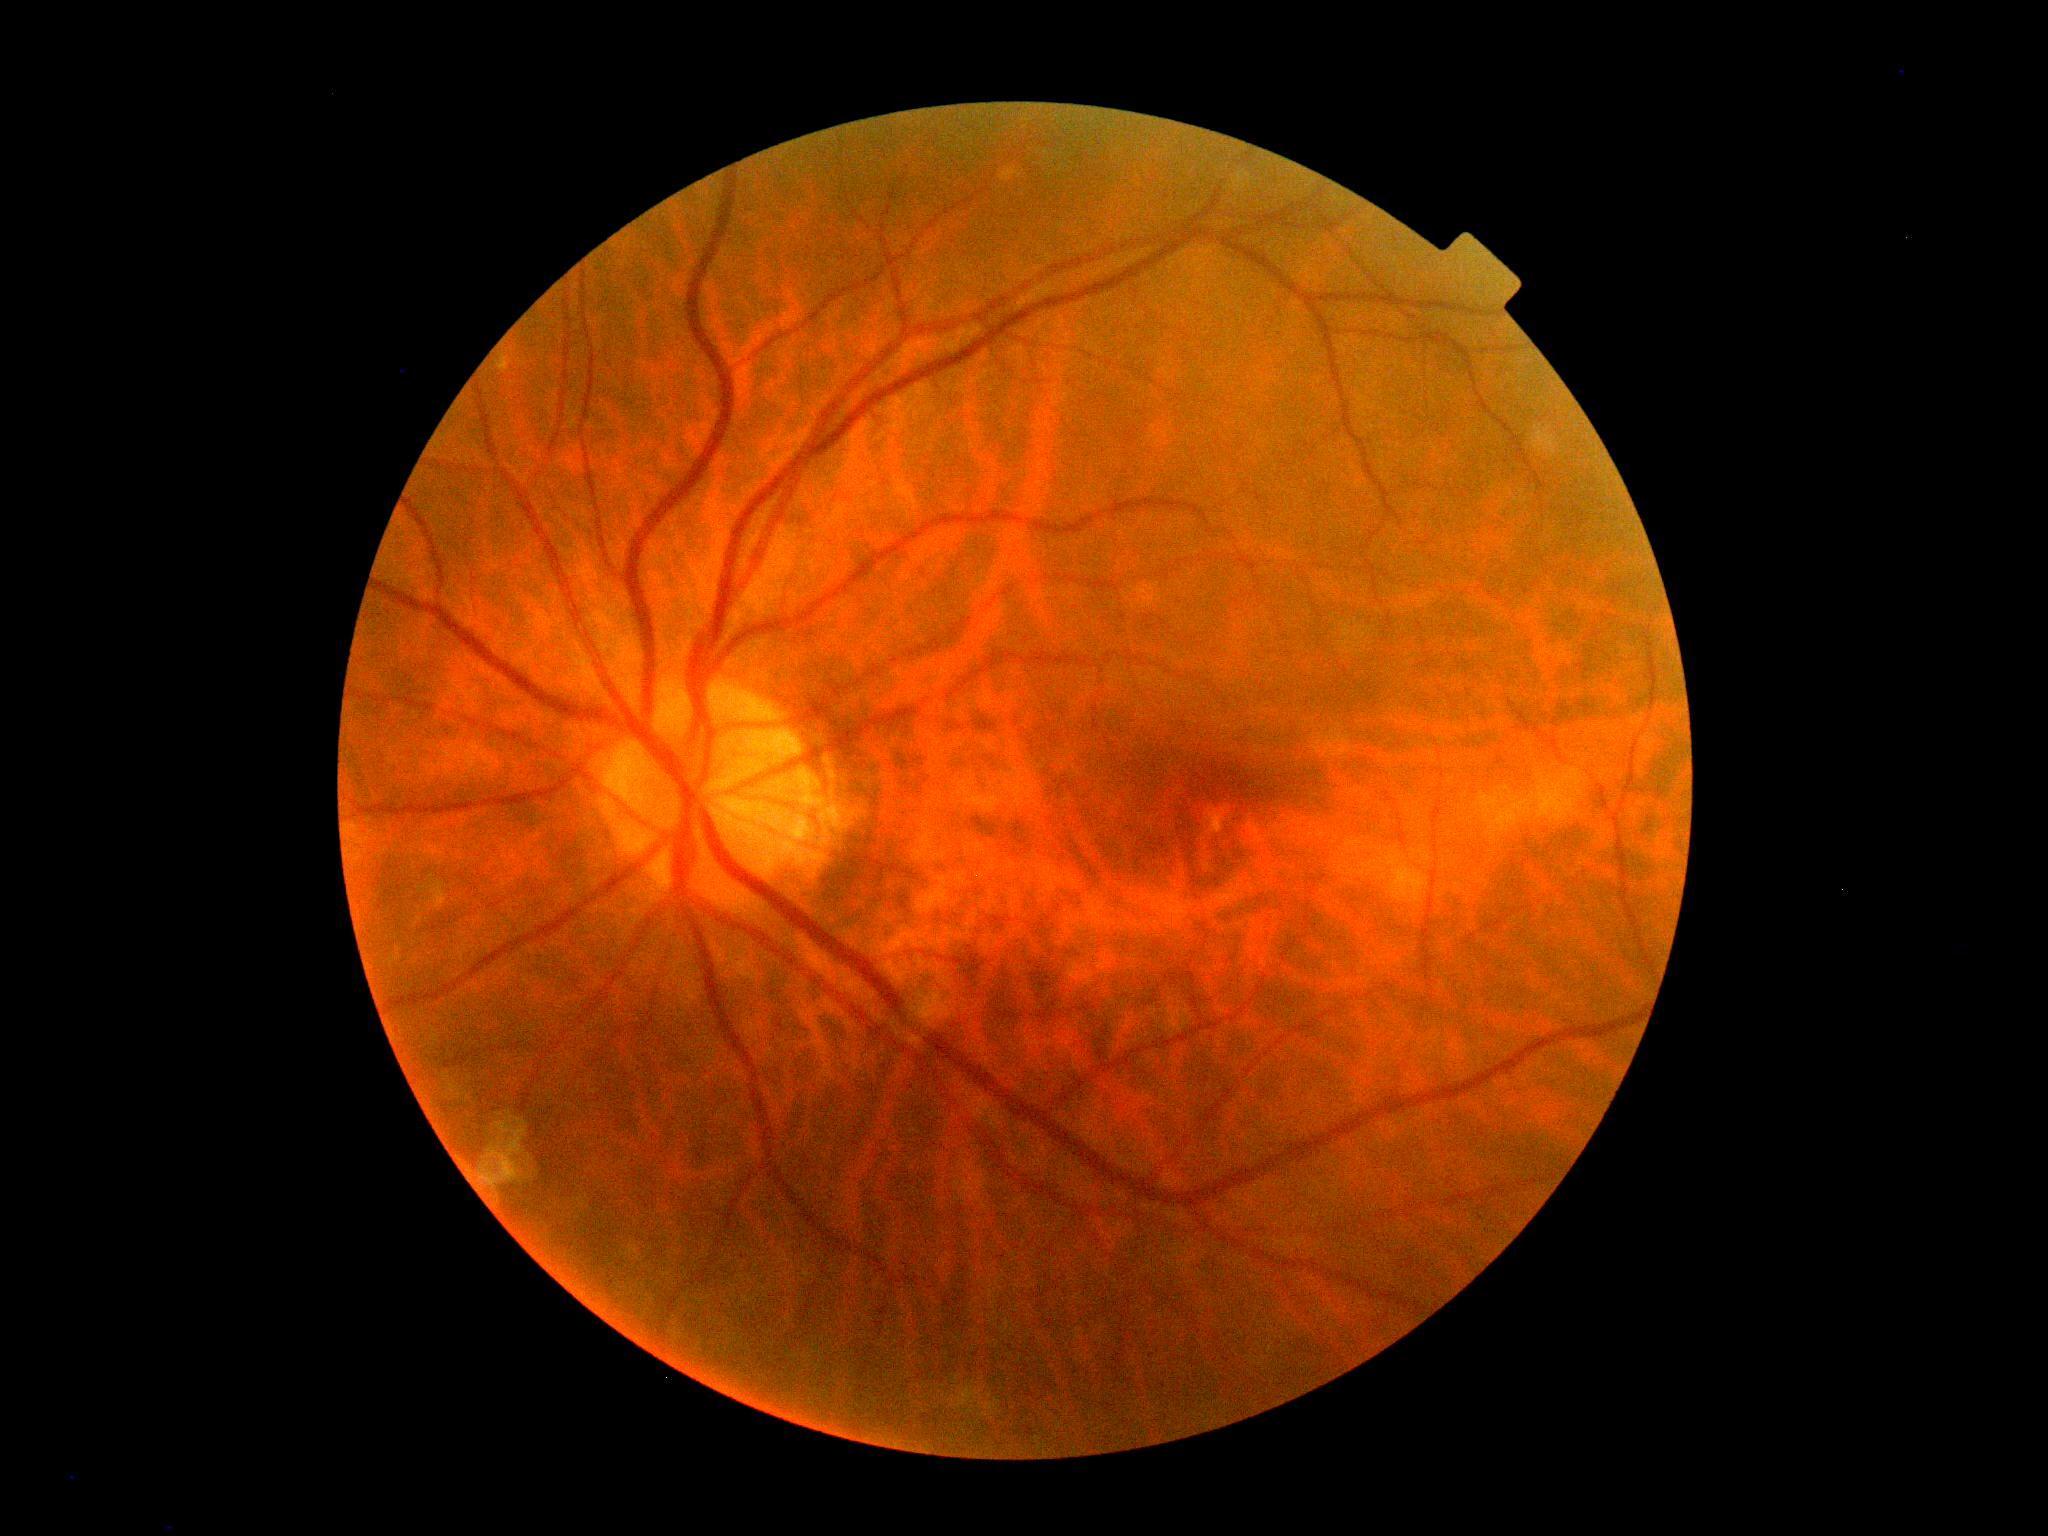
DR is 0/4 — no visible signs of diabetic retinopathy.